45° field of view: 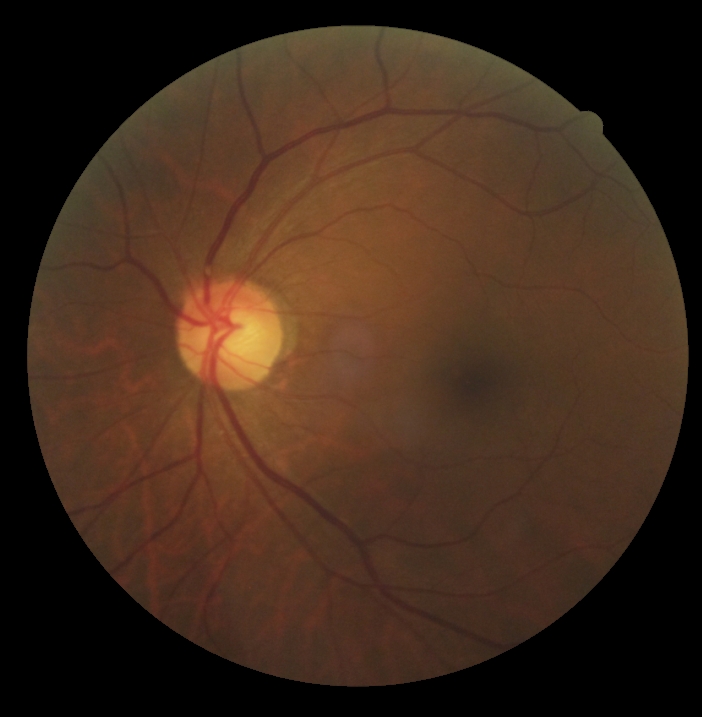
DR impression = no apparent DR, retinopathy = grade 0.